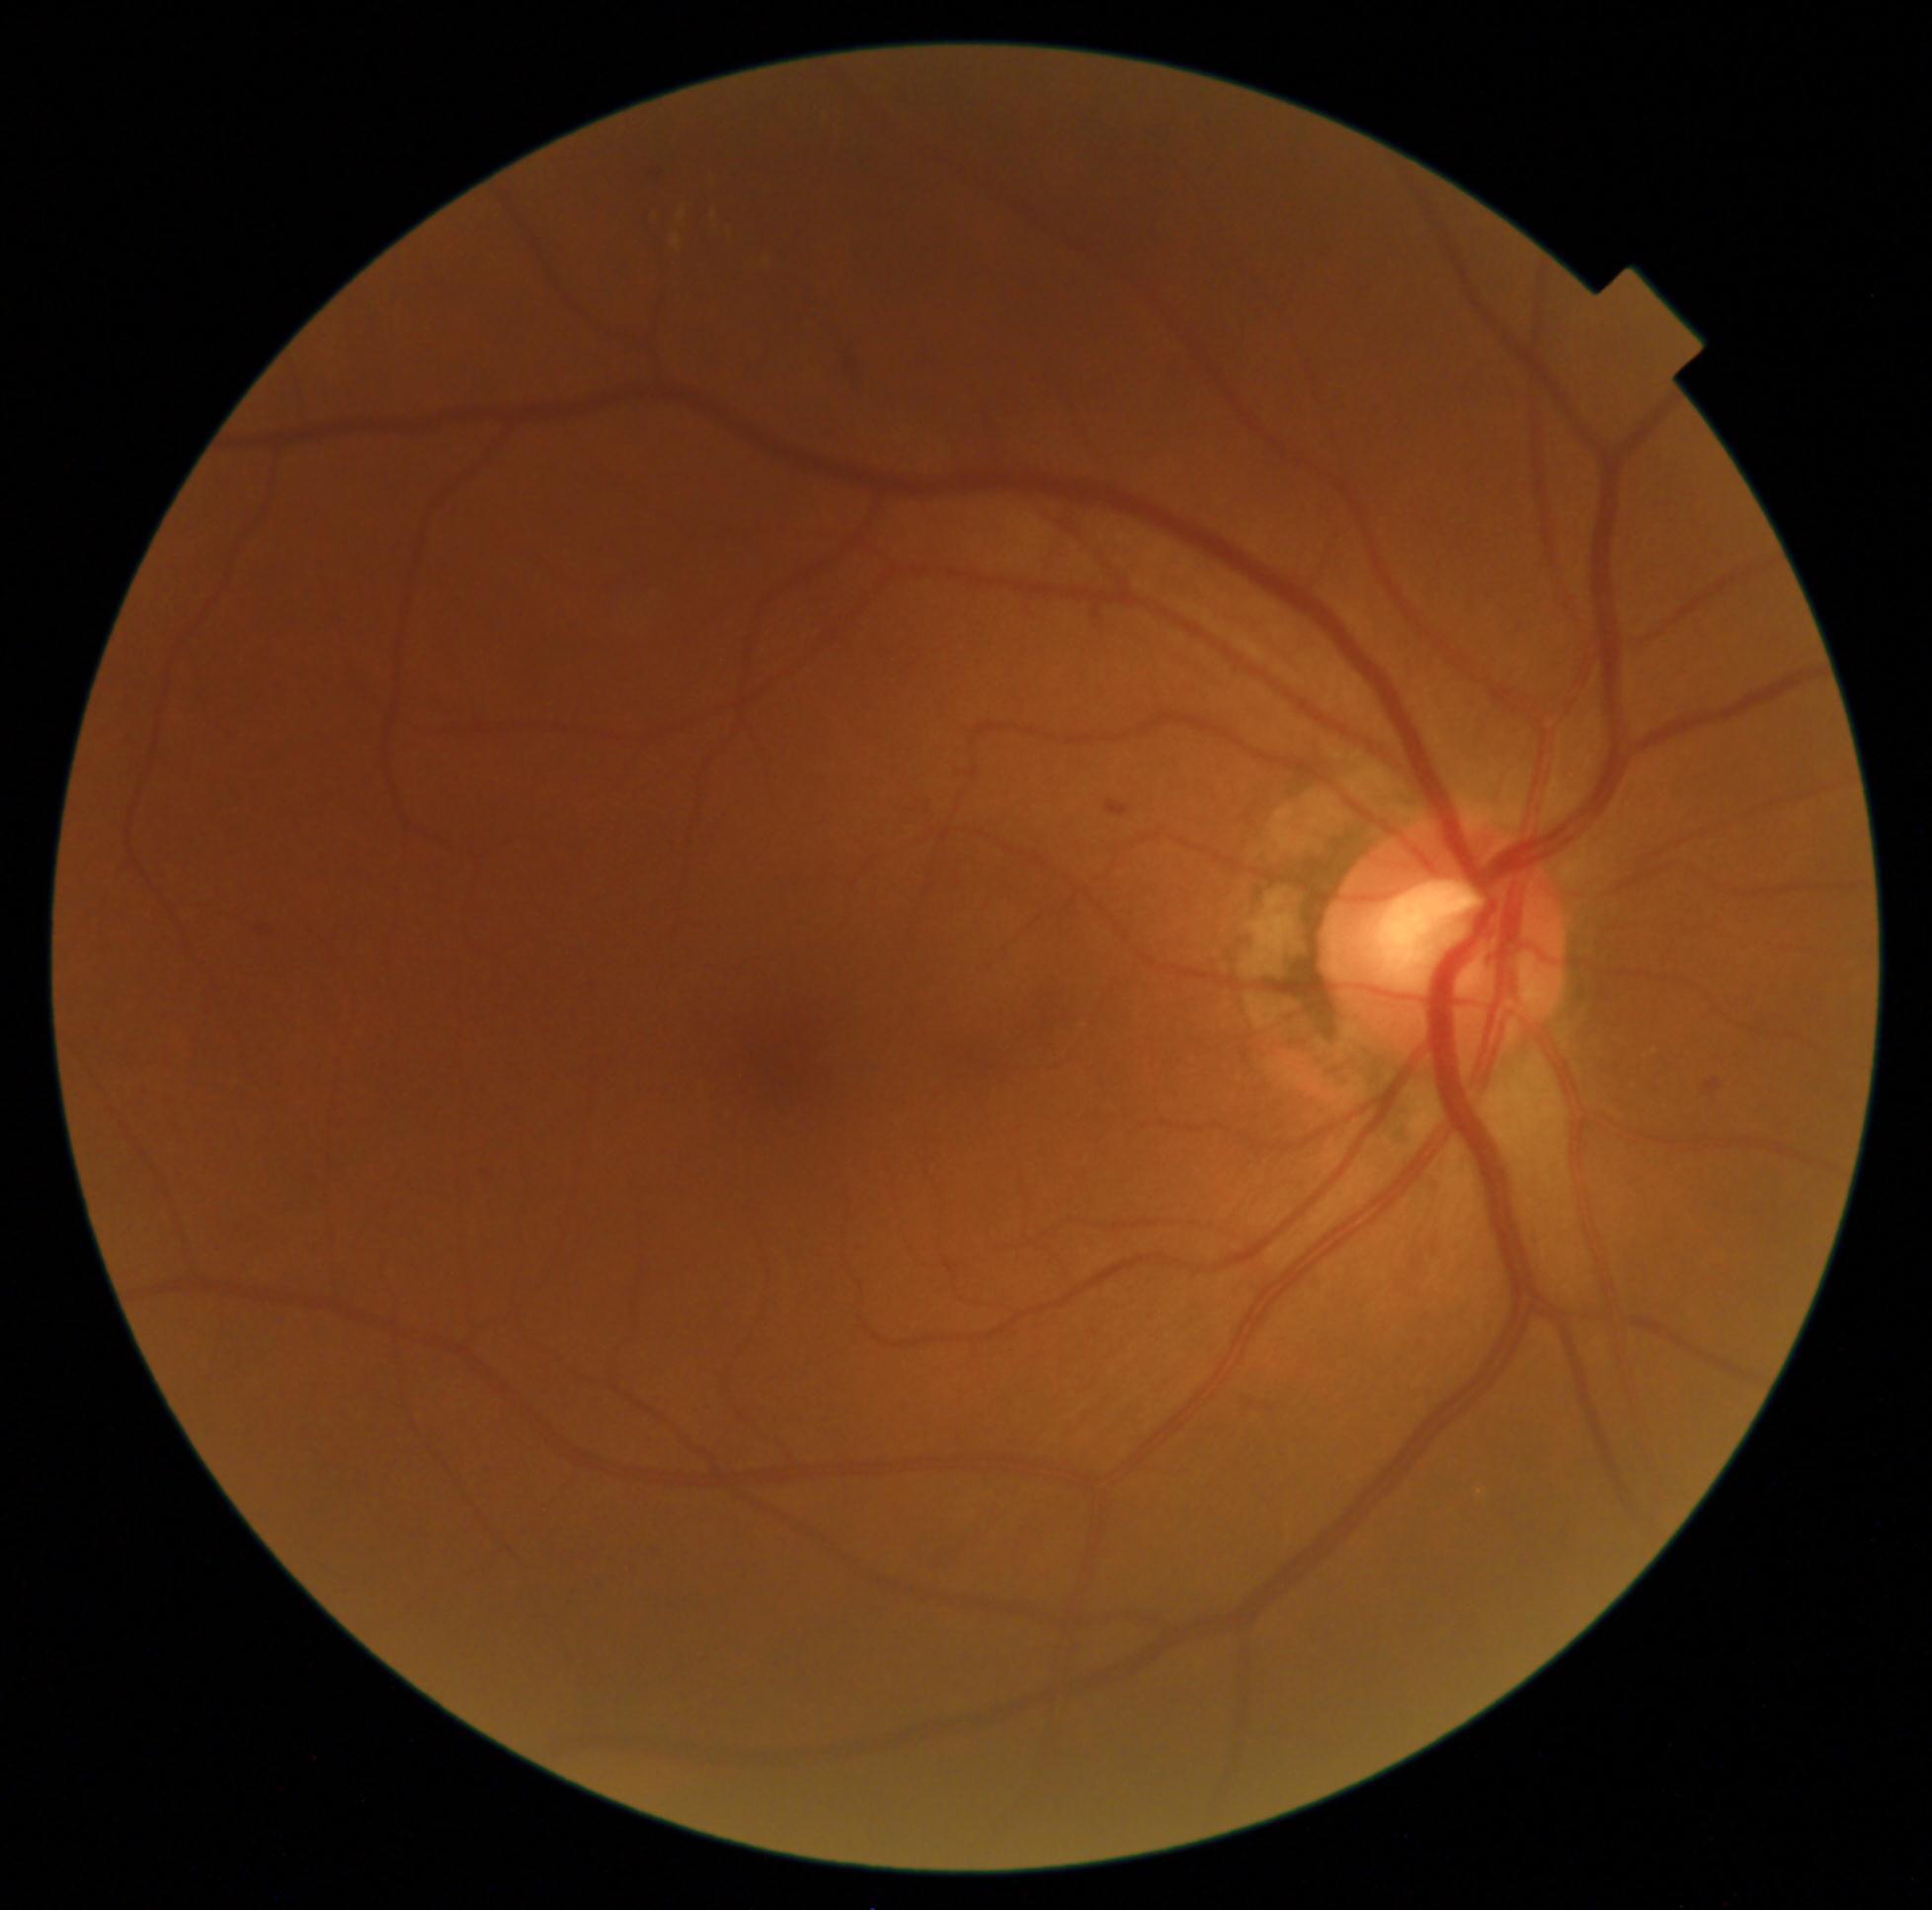 DR severity: moderate NPDR (grade 2); DR class: non-proliferative diabetic retinopathy.